Pediatric wide-field fundus photograph
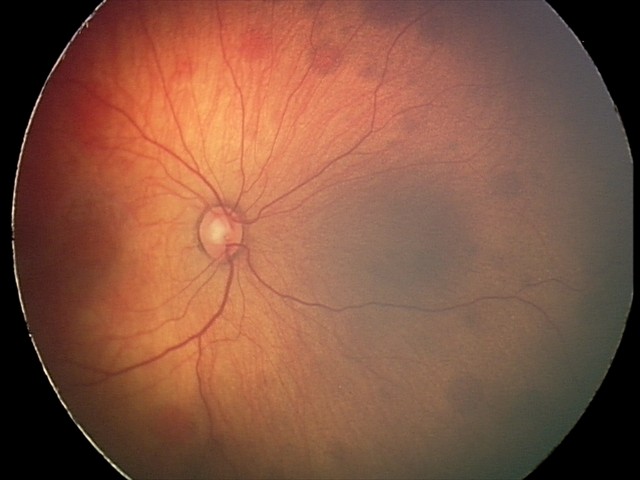

Screening examination consistent with retinal hemorrhages.